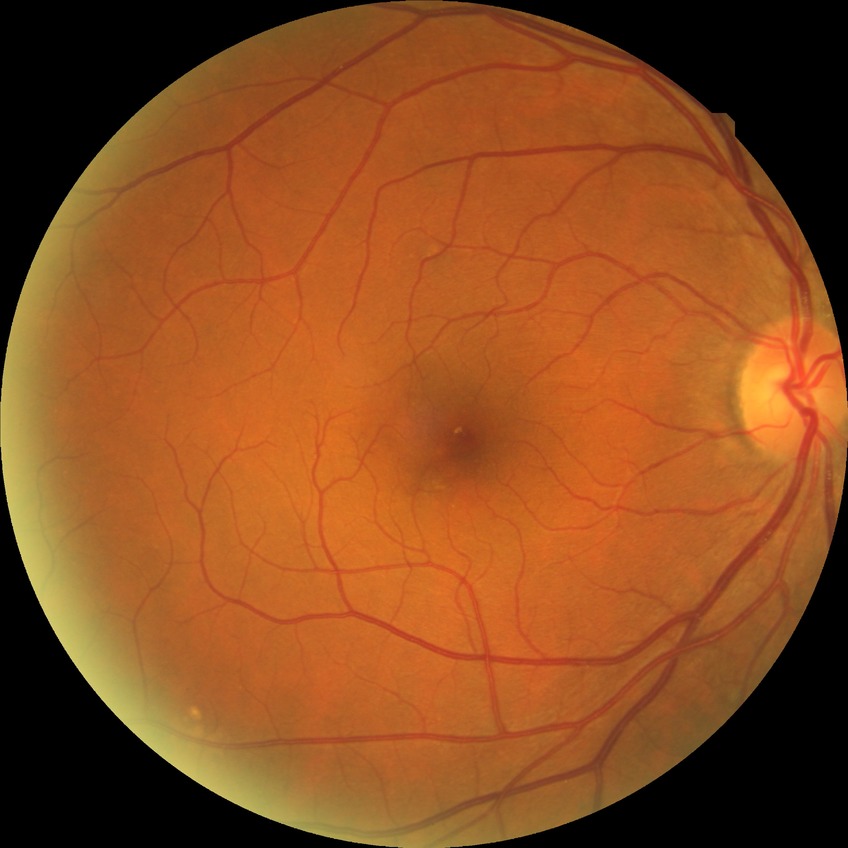

Davis grading: no diabetic retinopathy.